45° FOV:
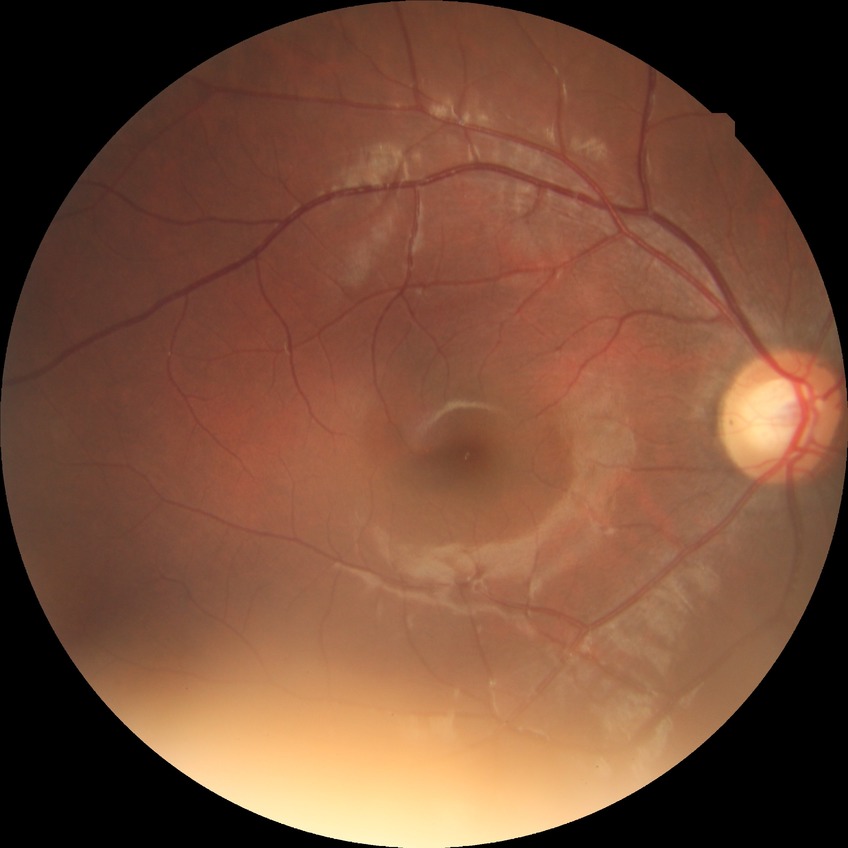 Modified Davis classification: no diabetic retinopathy.